Captured with the Phoenix ICON (100° field of view); pediatric wide-field fundus photograph
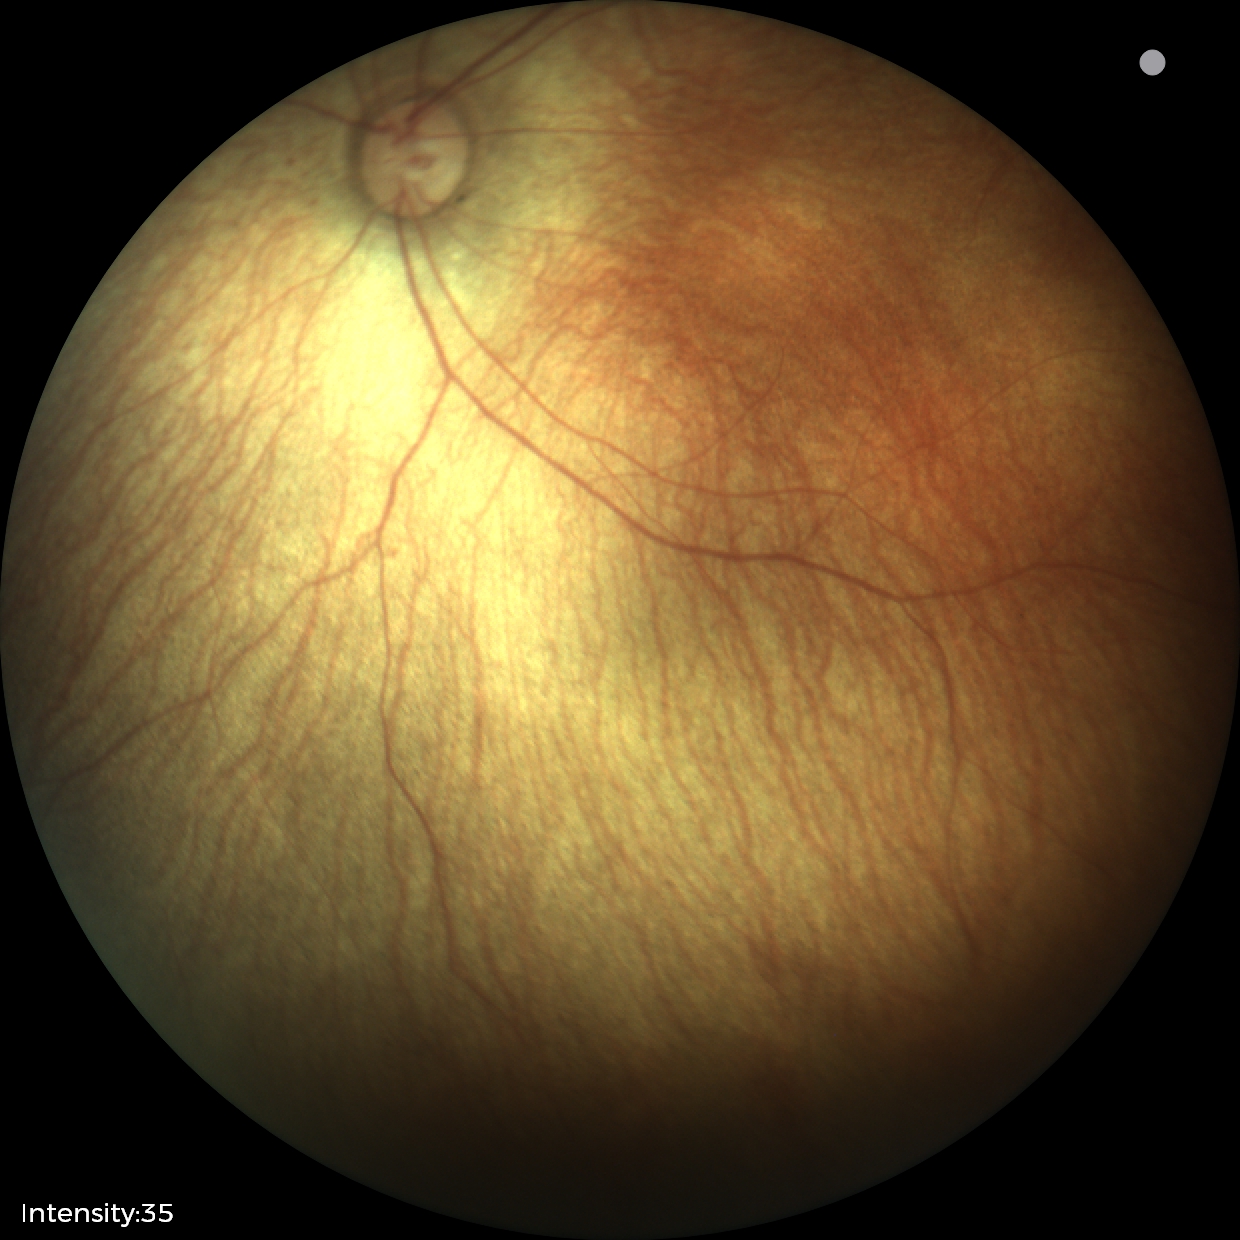

Screening examination with no abnormal retinal findings.